2212x1659; 60-degree field of view; portable fundus photograph
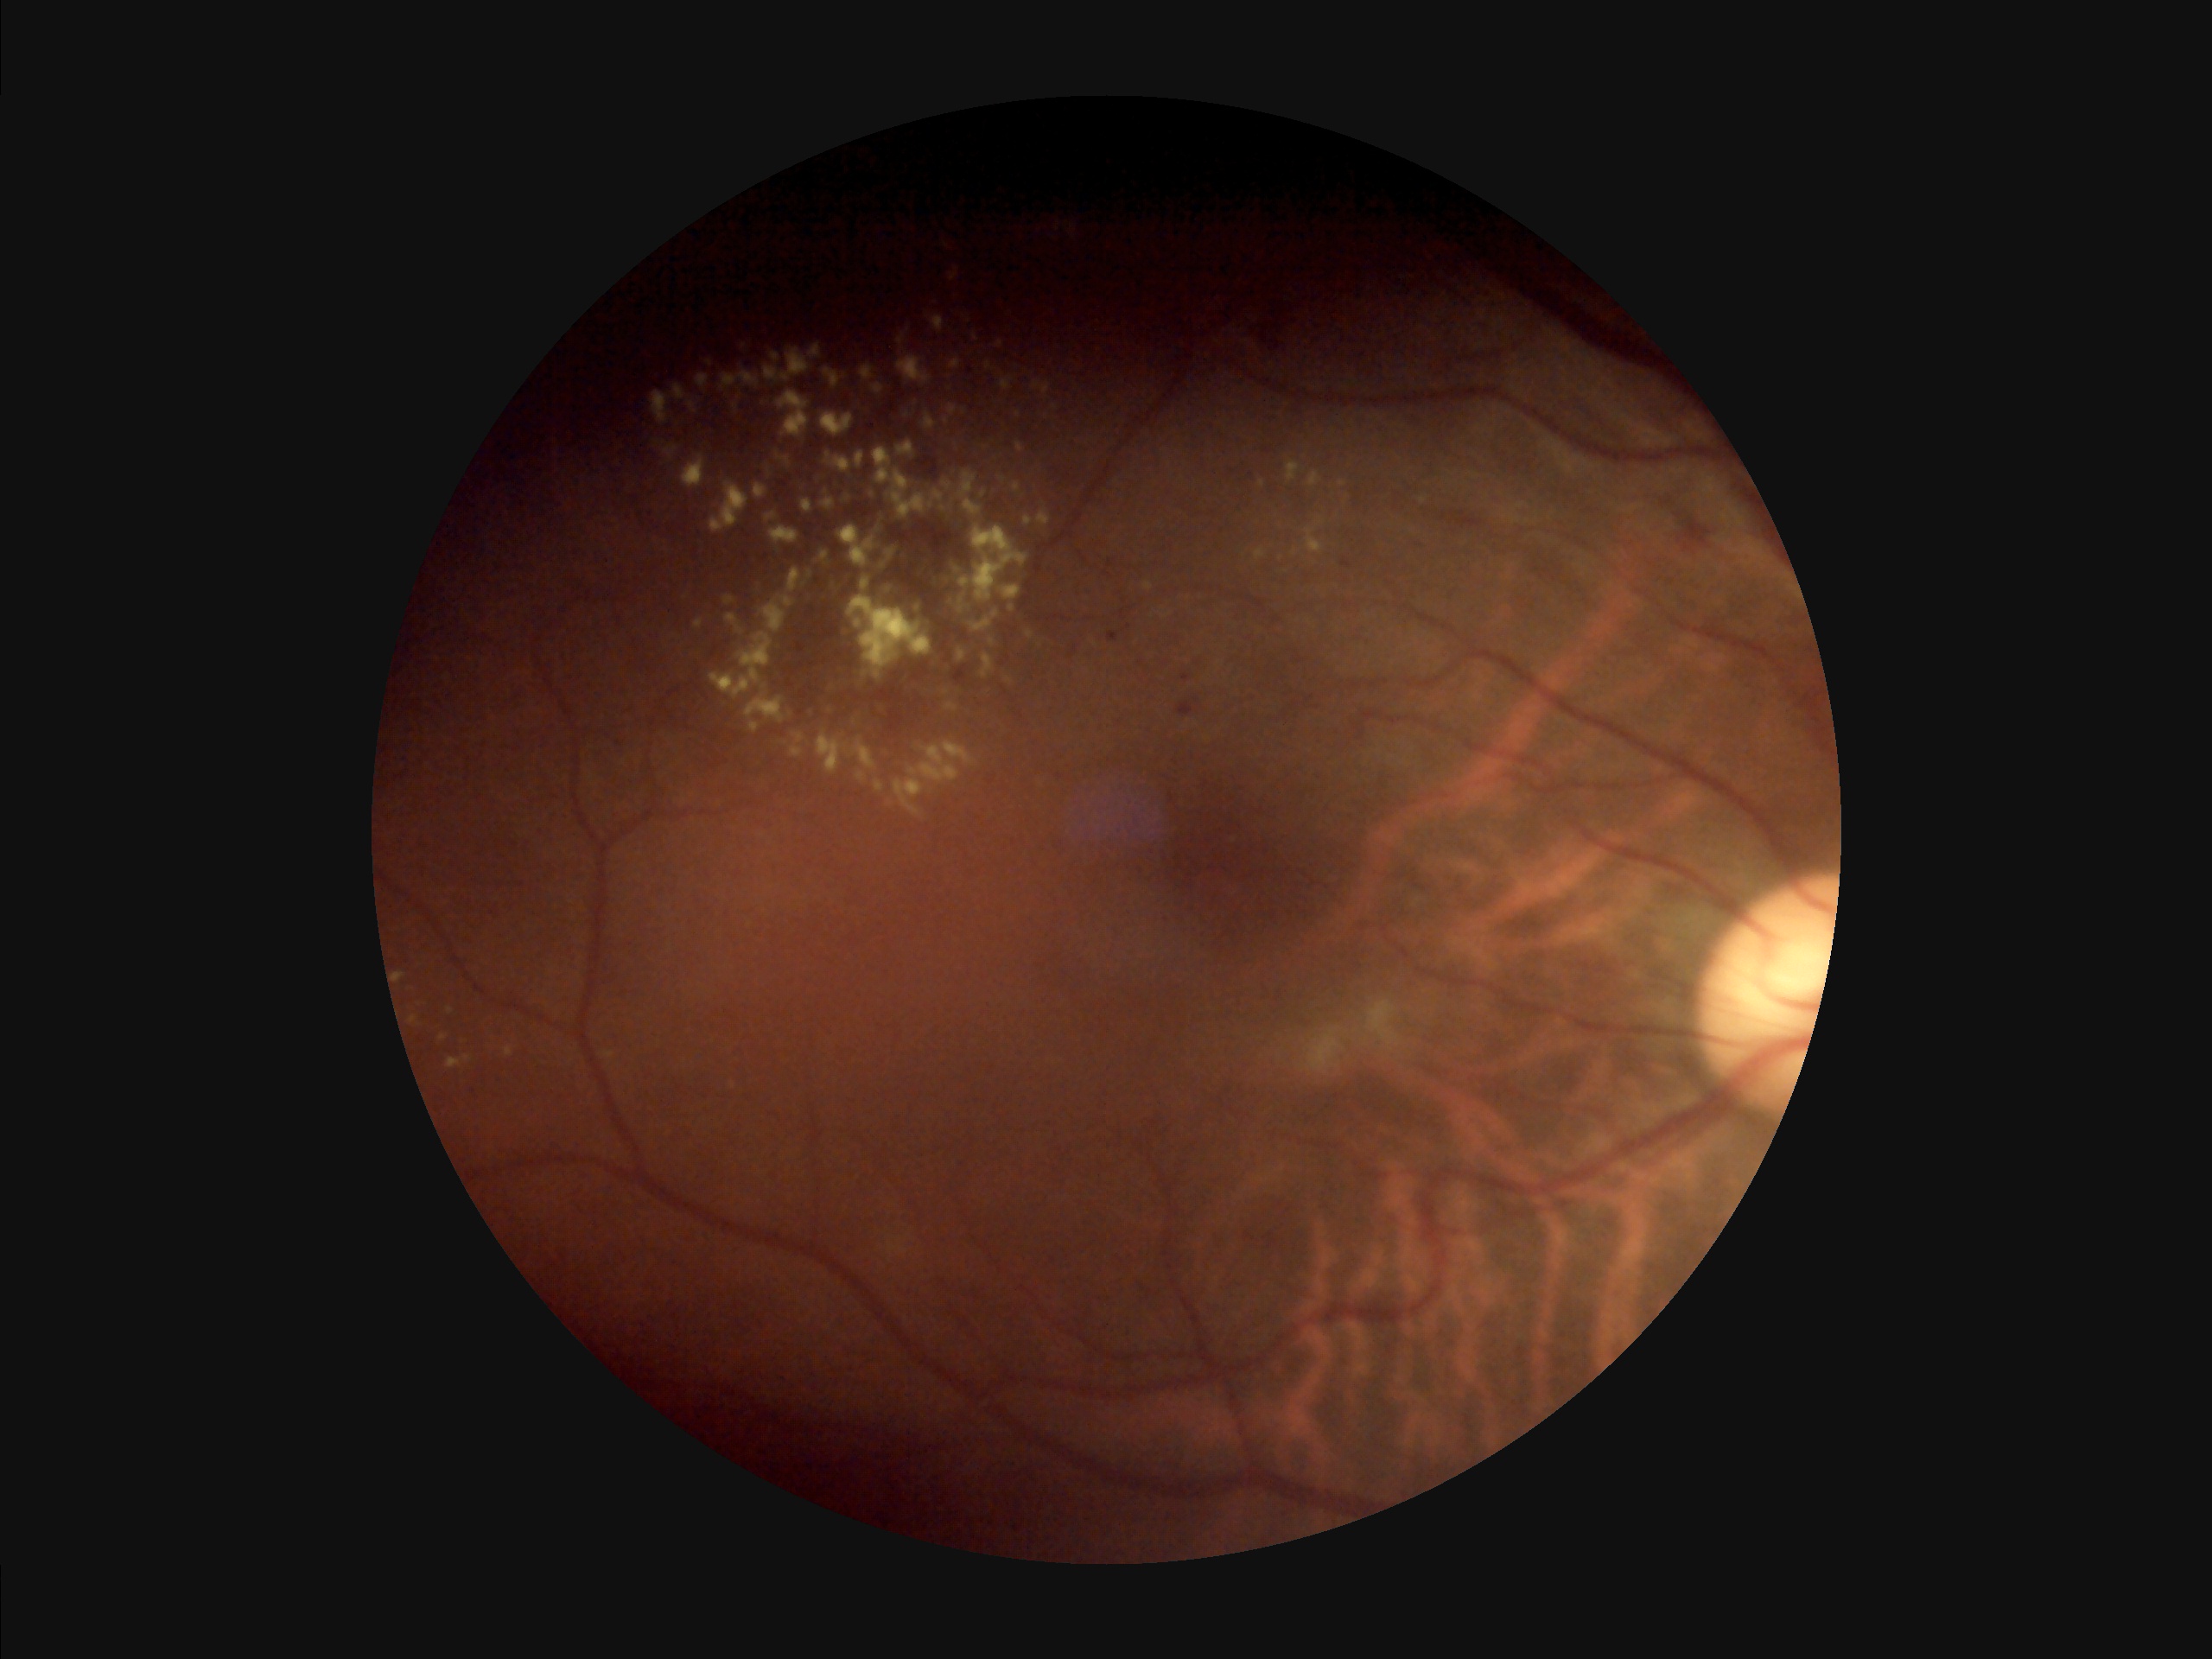
Image quality:
- contrast: poor
- overall: low
- illumination/color: suboptimal